Wide-field fundus image from infant ROP screening.
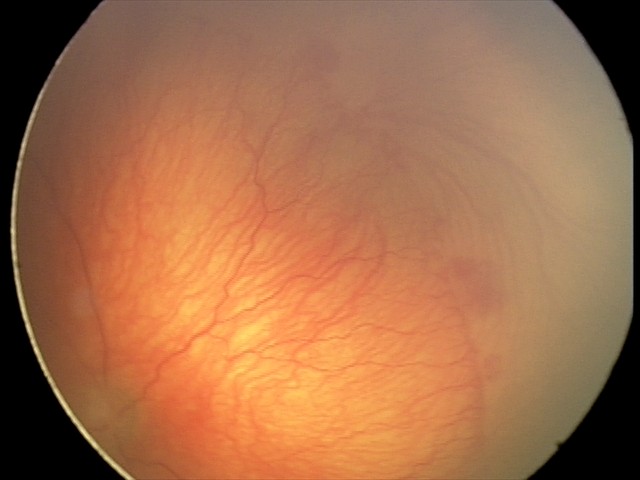 Screening examination consistent with aggressive retinopathy of prematurity.